Infant wide-field retinal image:
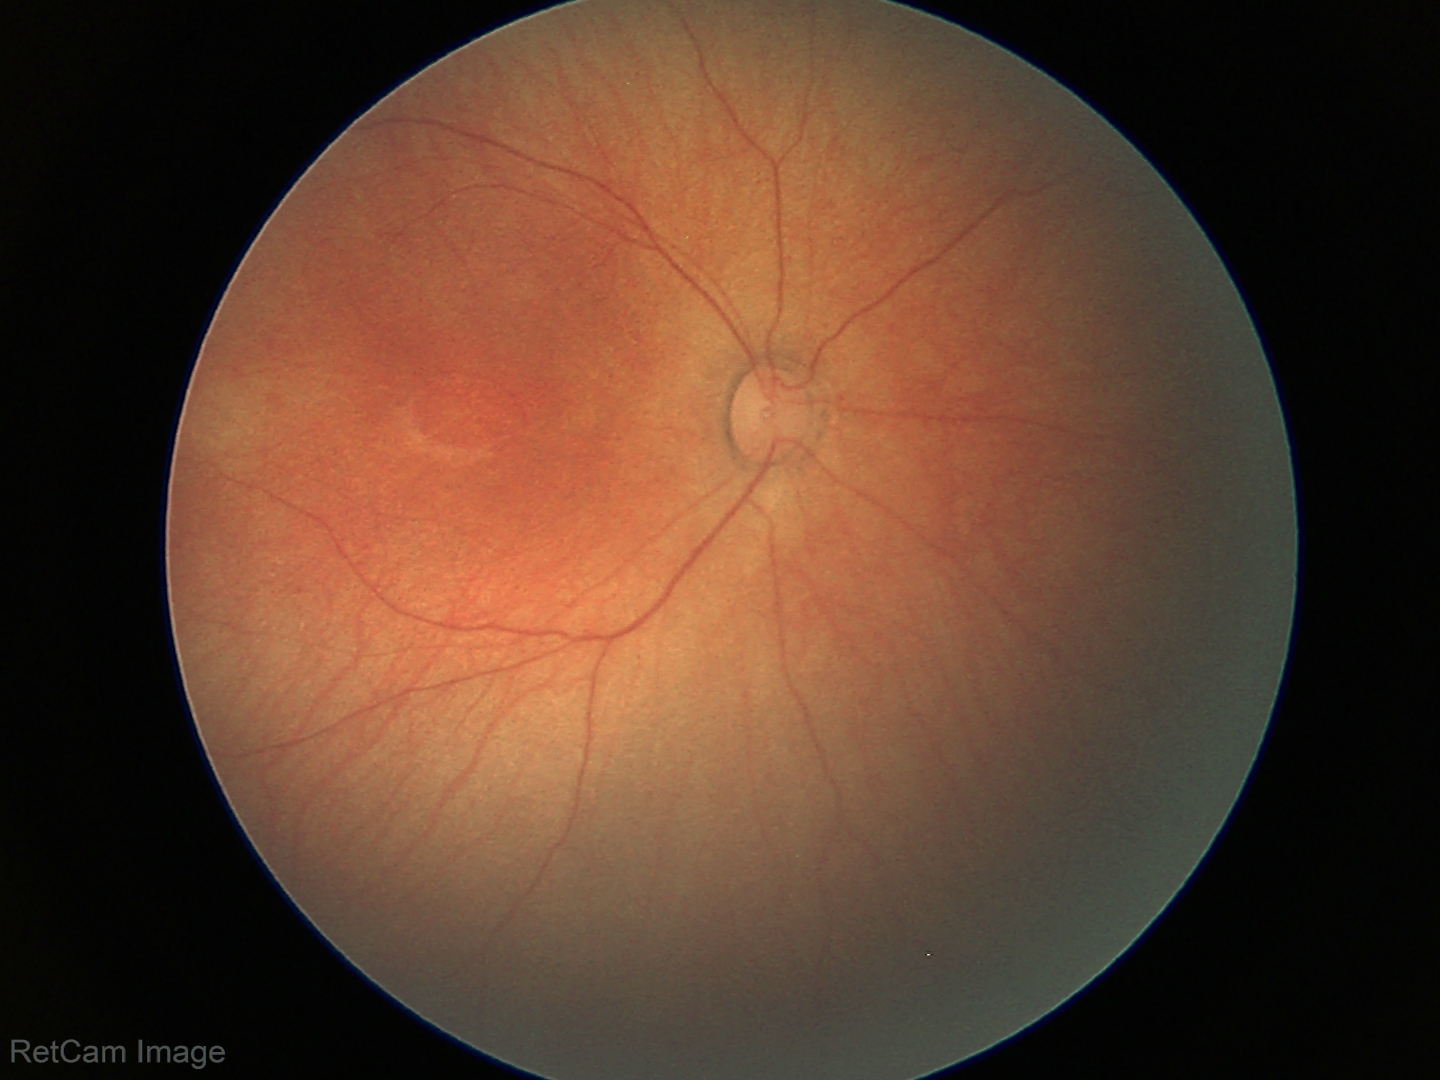
Finding: normal.